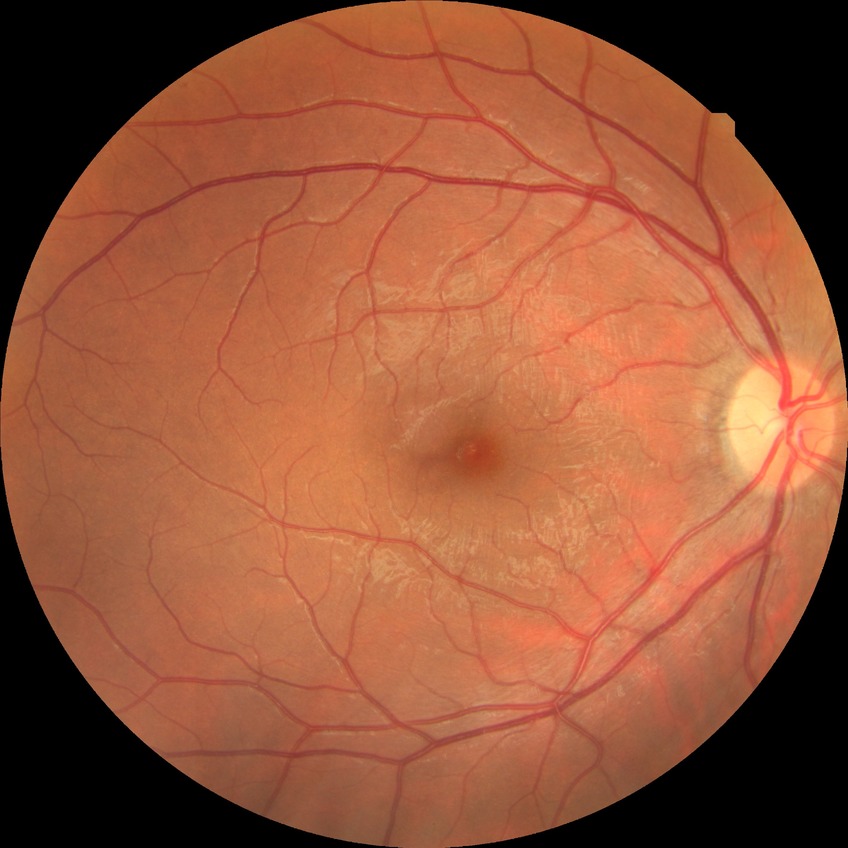 Diabetic retinopathy (DR): NDR (no diabetic retinopathy).